1932 x 1932 pixels, CFP, 45-degree field of view: 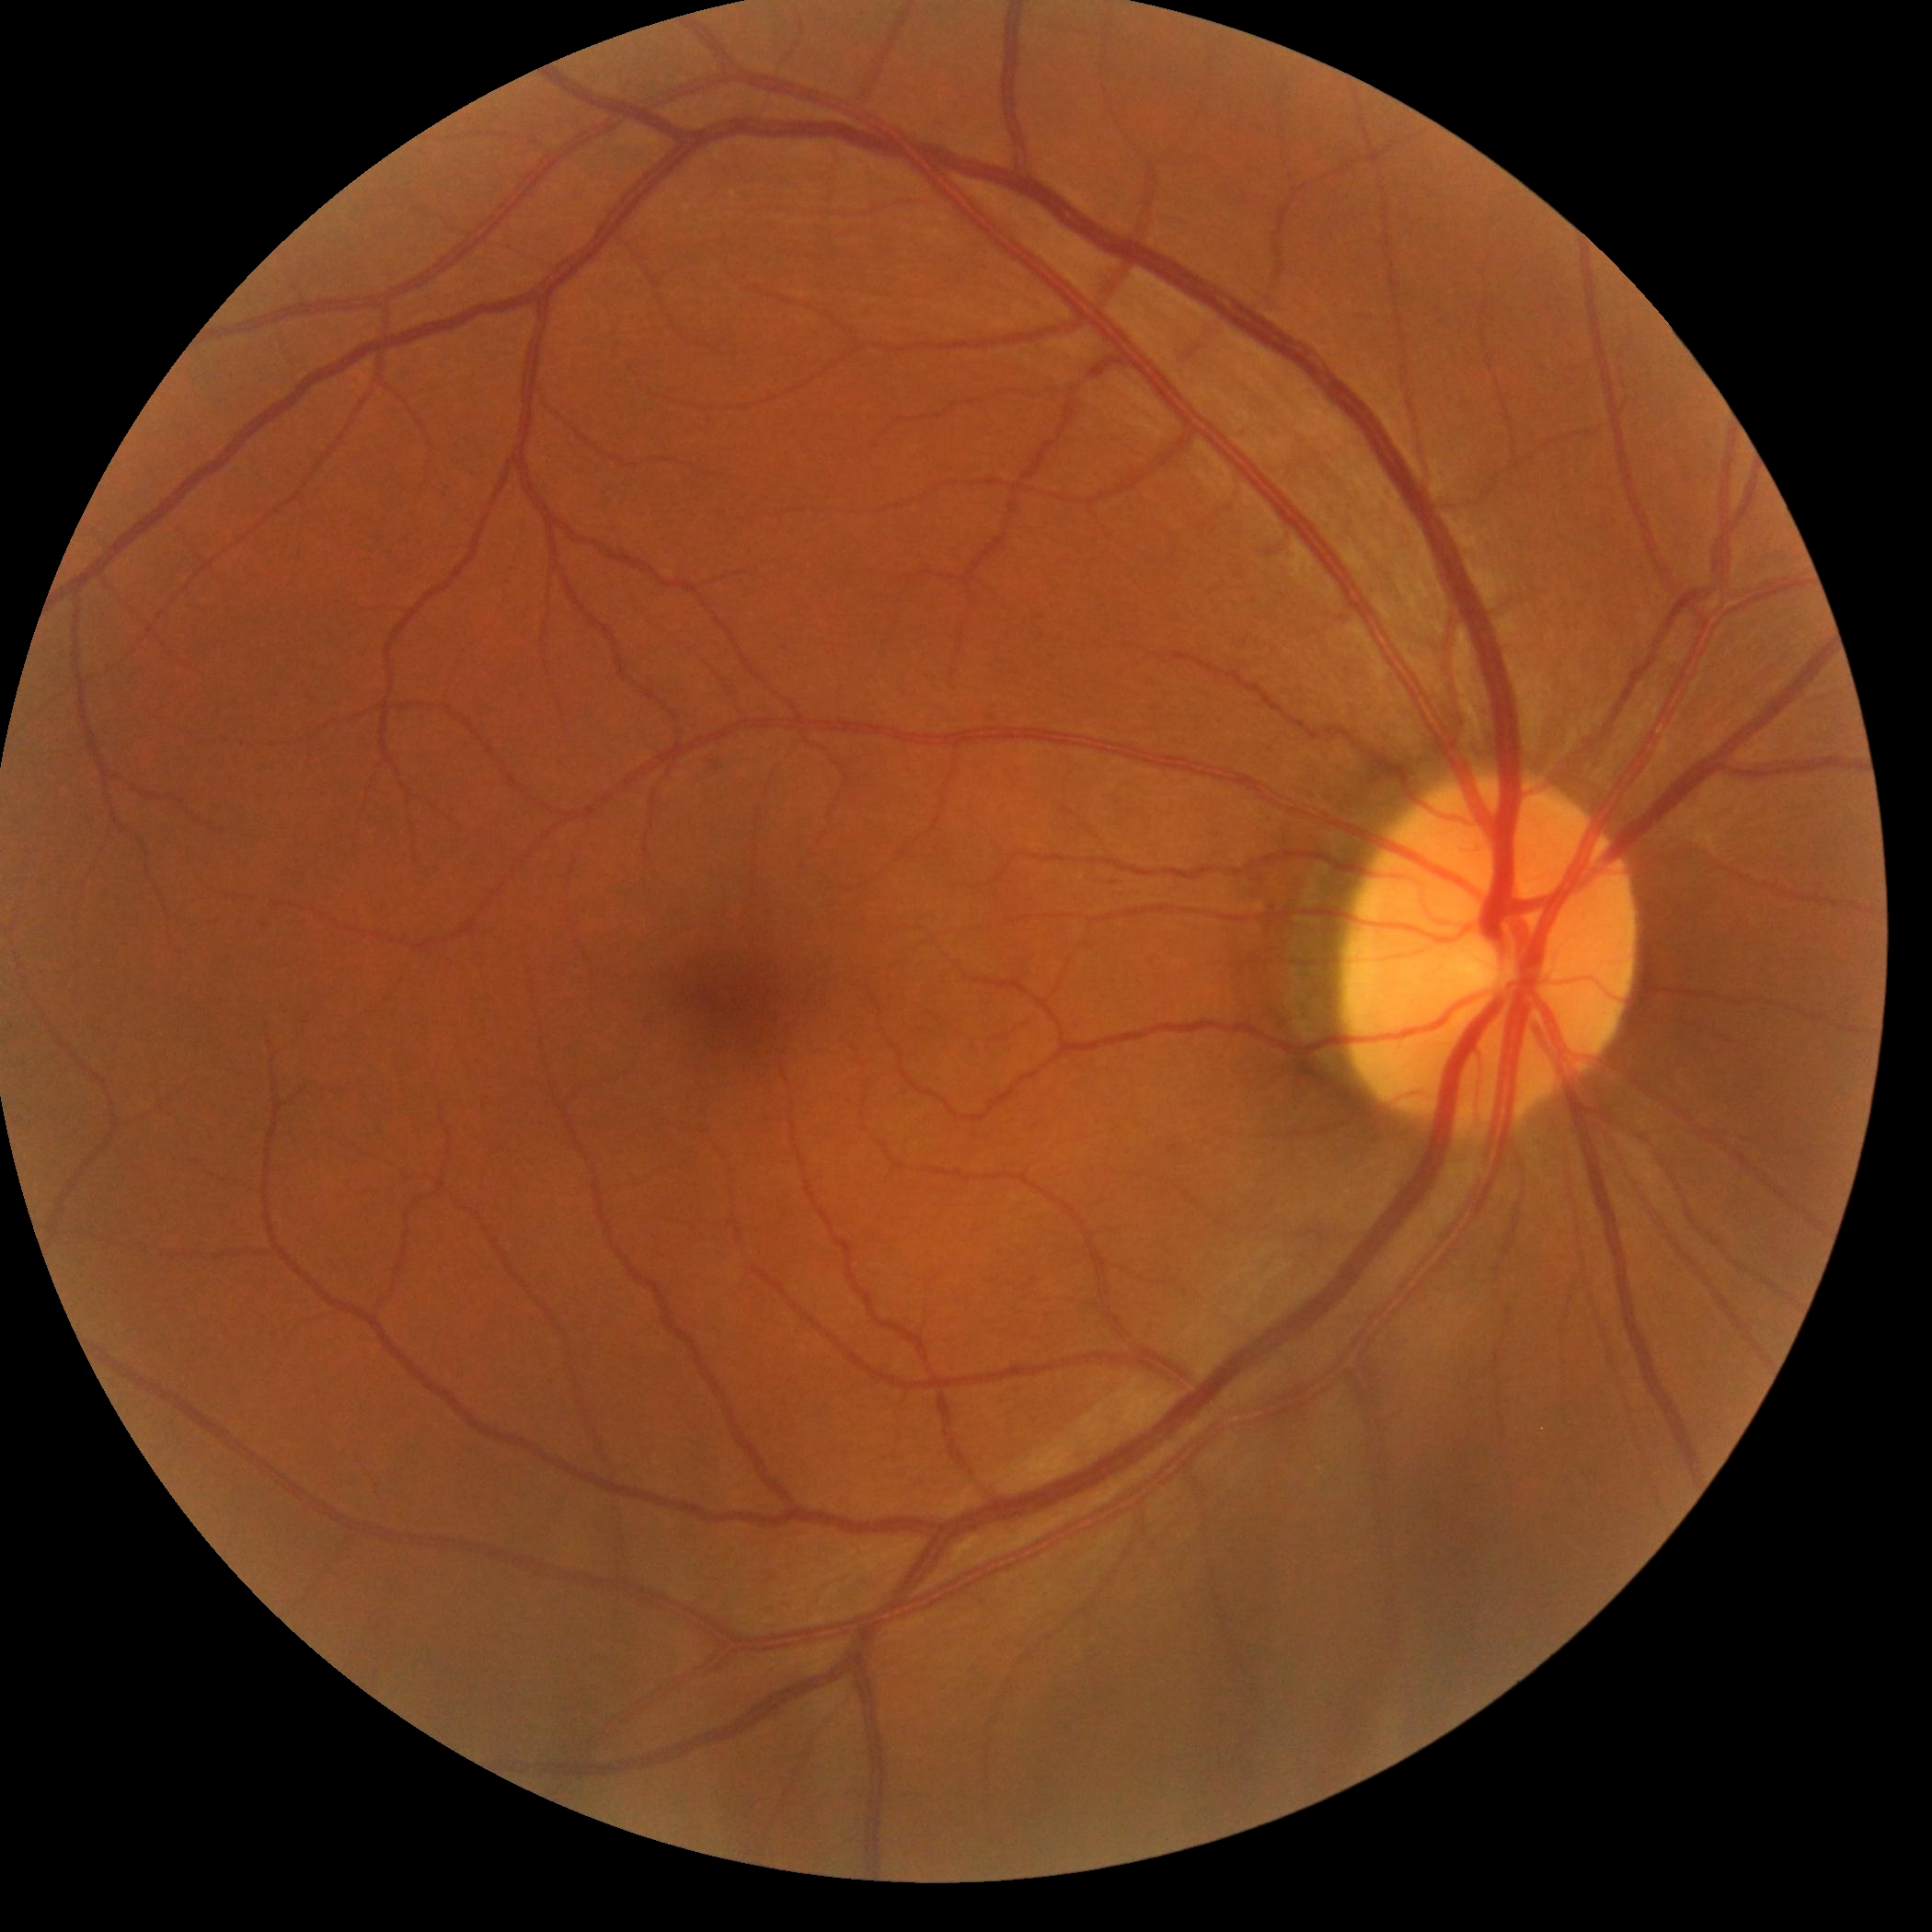

diabetic retinopathy grade = 0 — no visible signs of diabetic retinopathy.